2352x1568px: 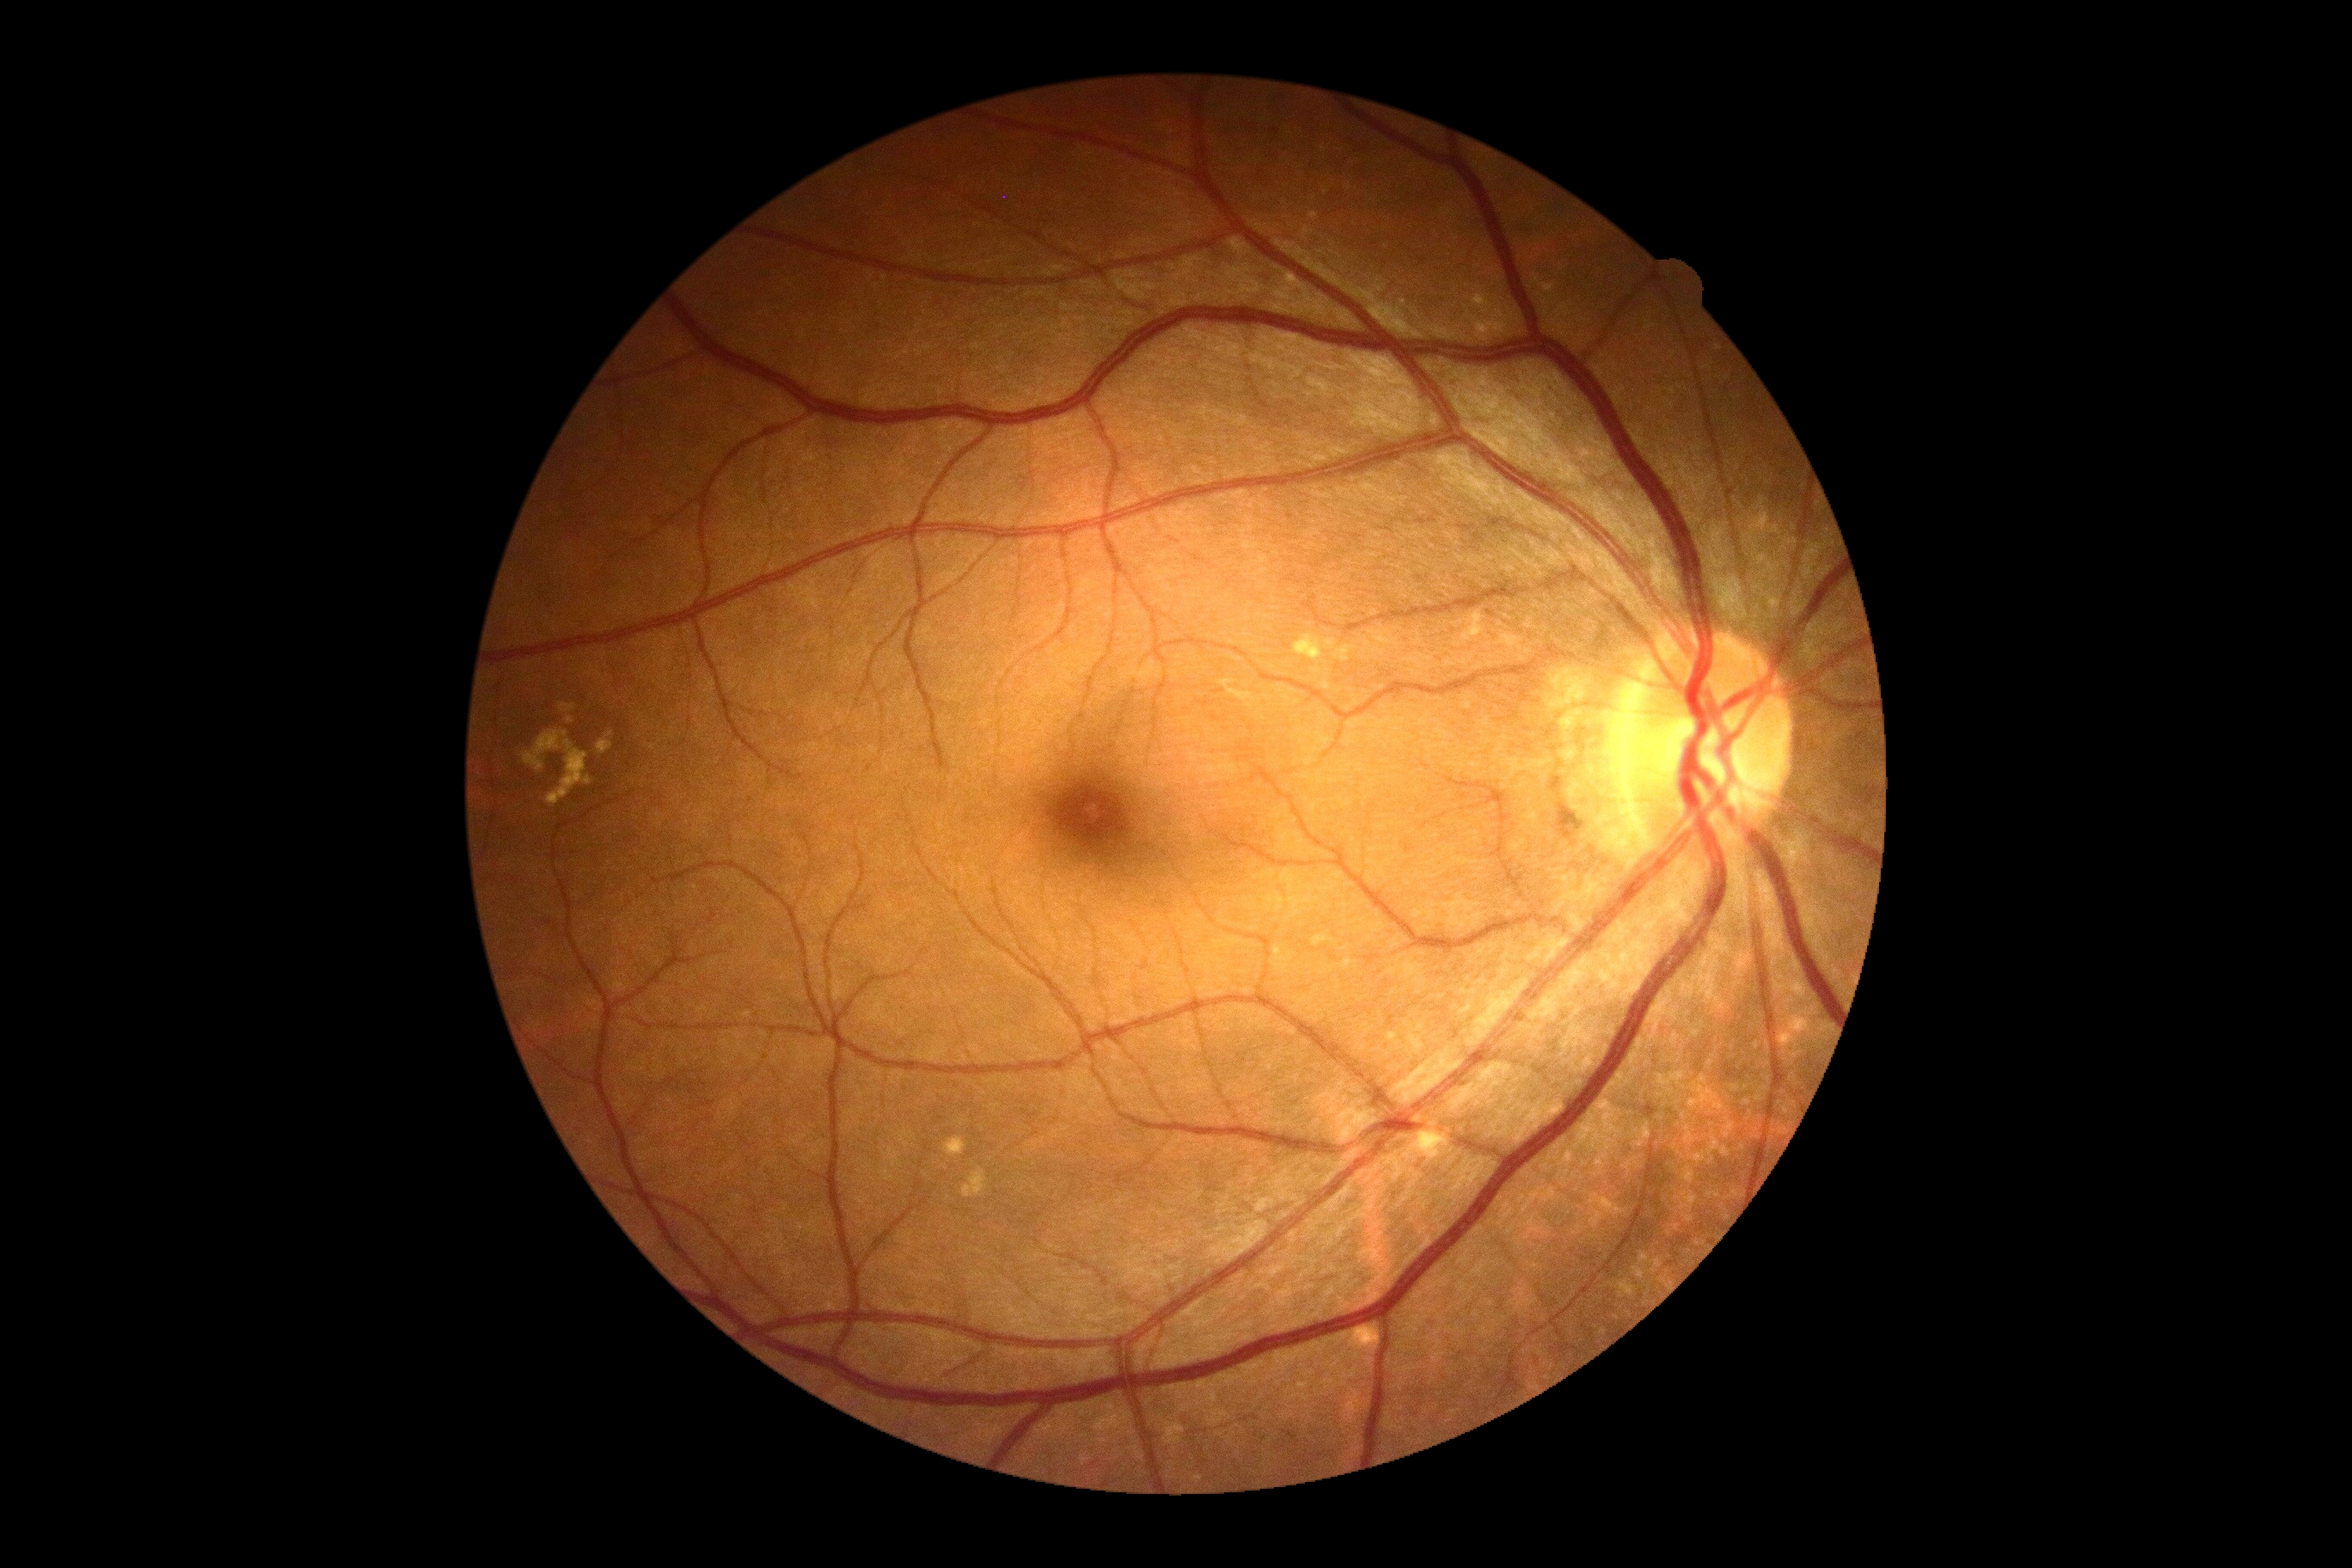 – DR impression: no DR findings
– retinopathy: grade 0